Without pupil dilation; Davis DR grading.
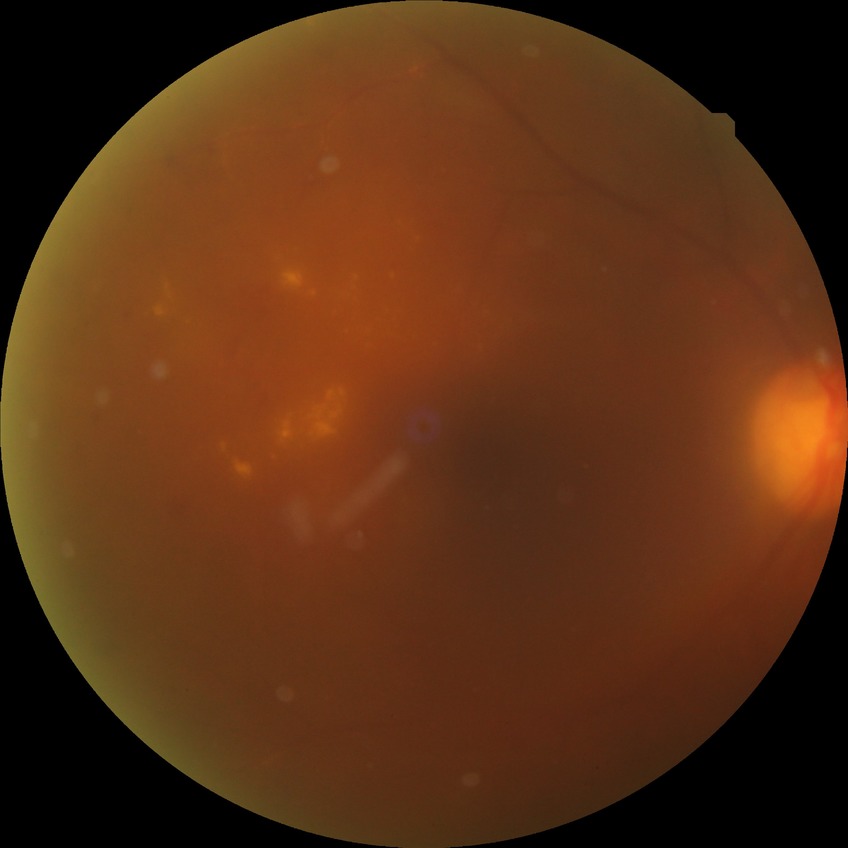
diabetic retinopathy (DR): PDR (proliferative diabetic retinopathy)